Pediatric wide-field fundus photograph: 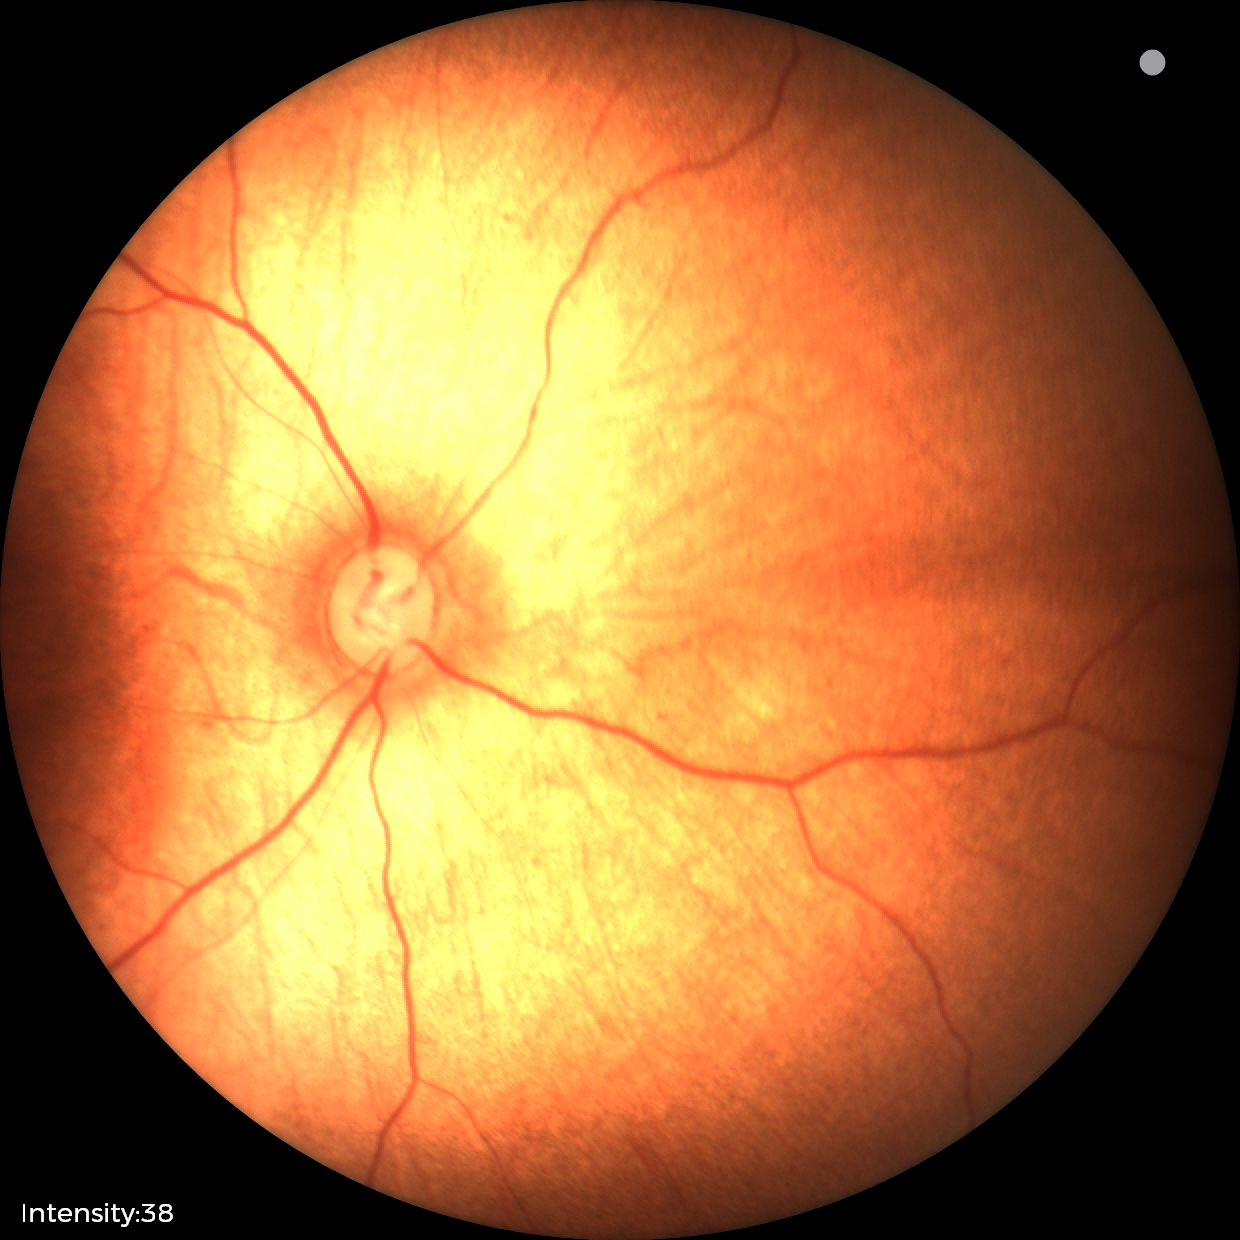 Screening diagnosis: normal fundus examination.